Image size 1932x1910 — 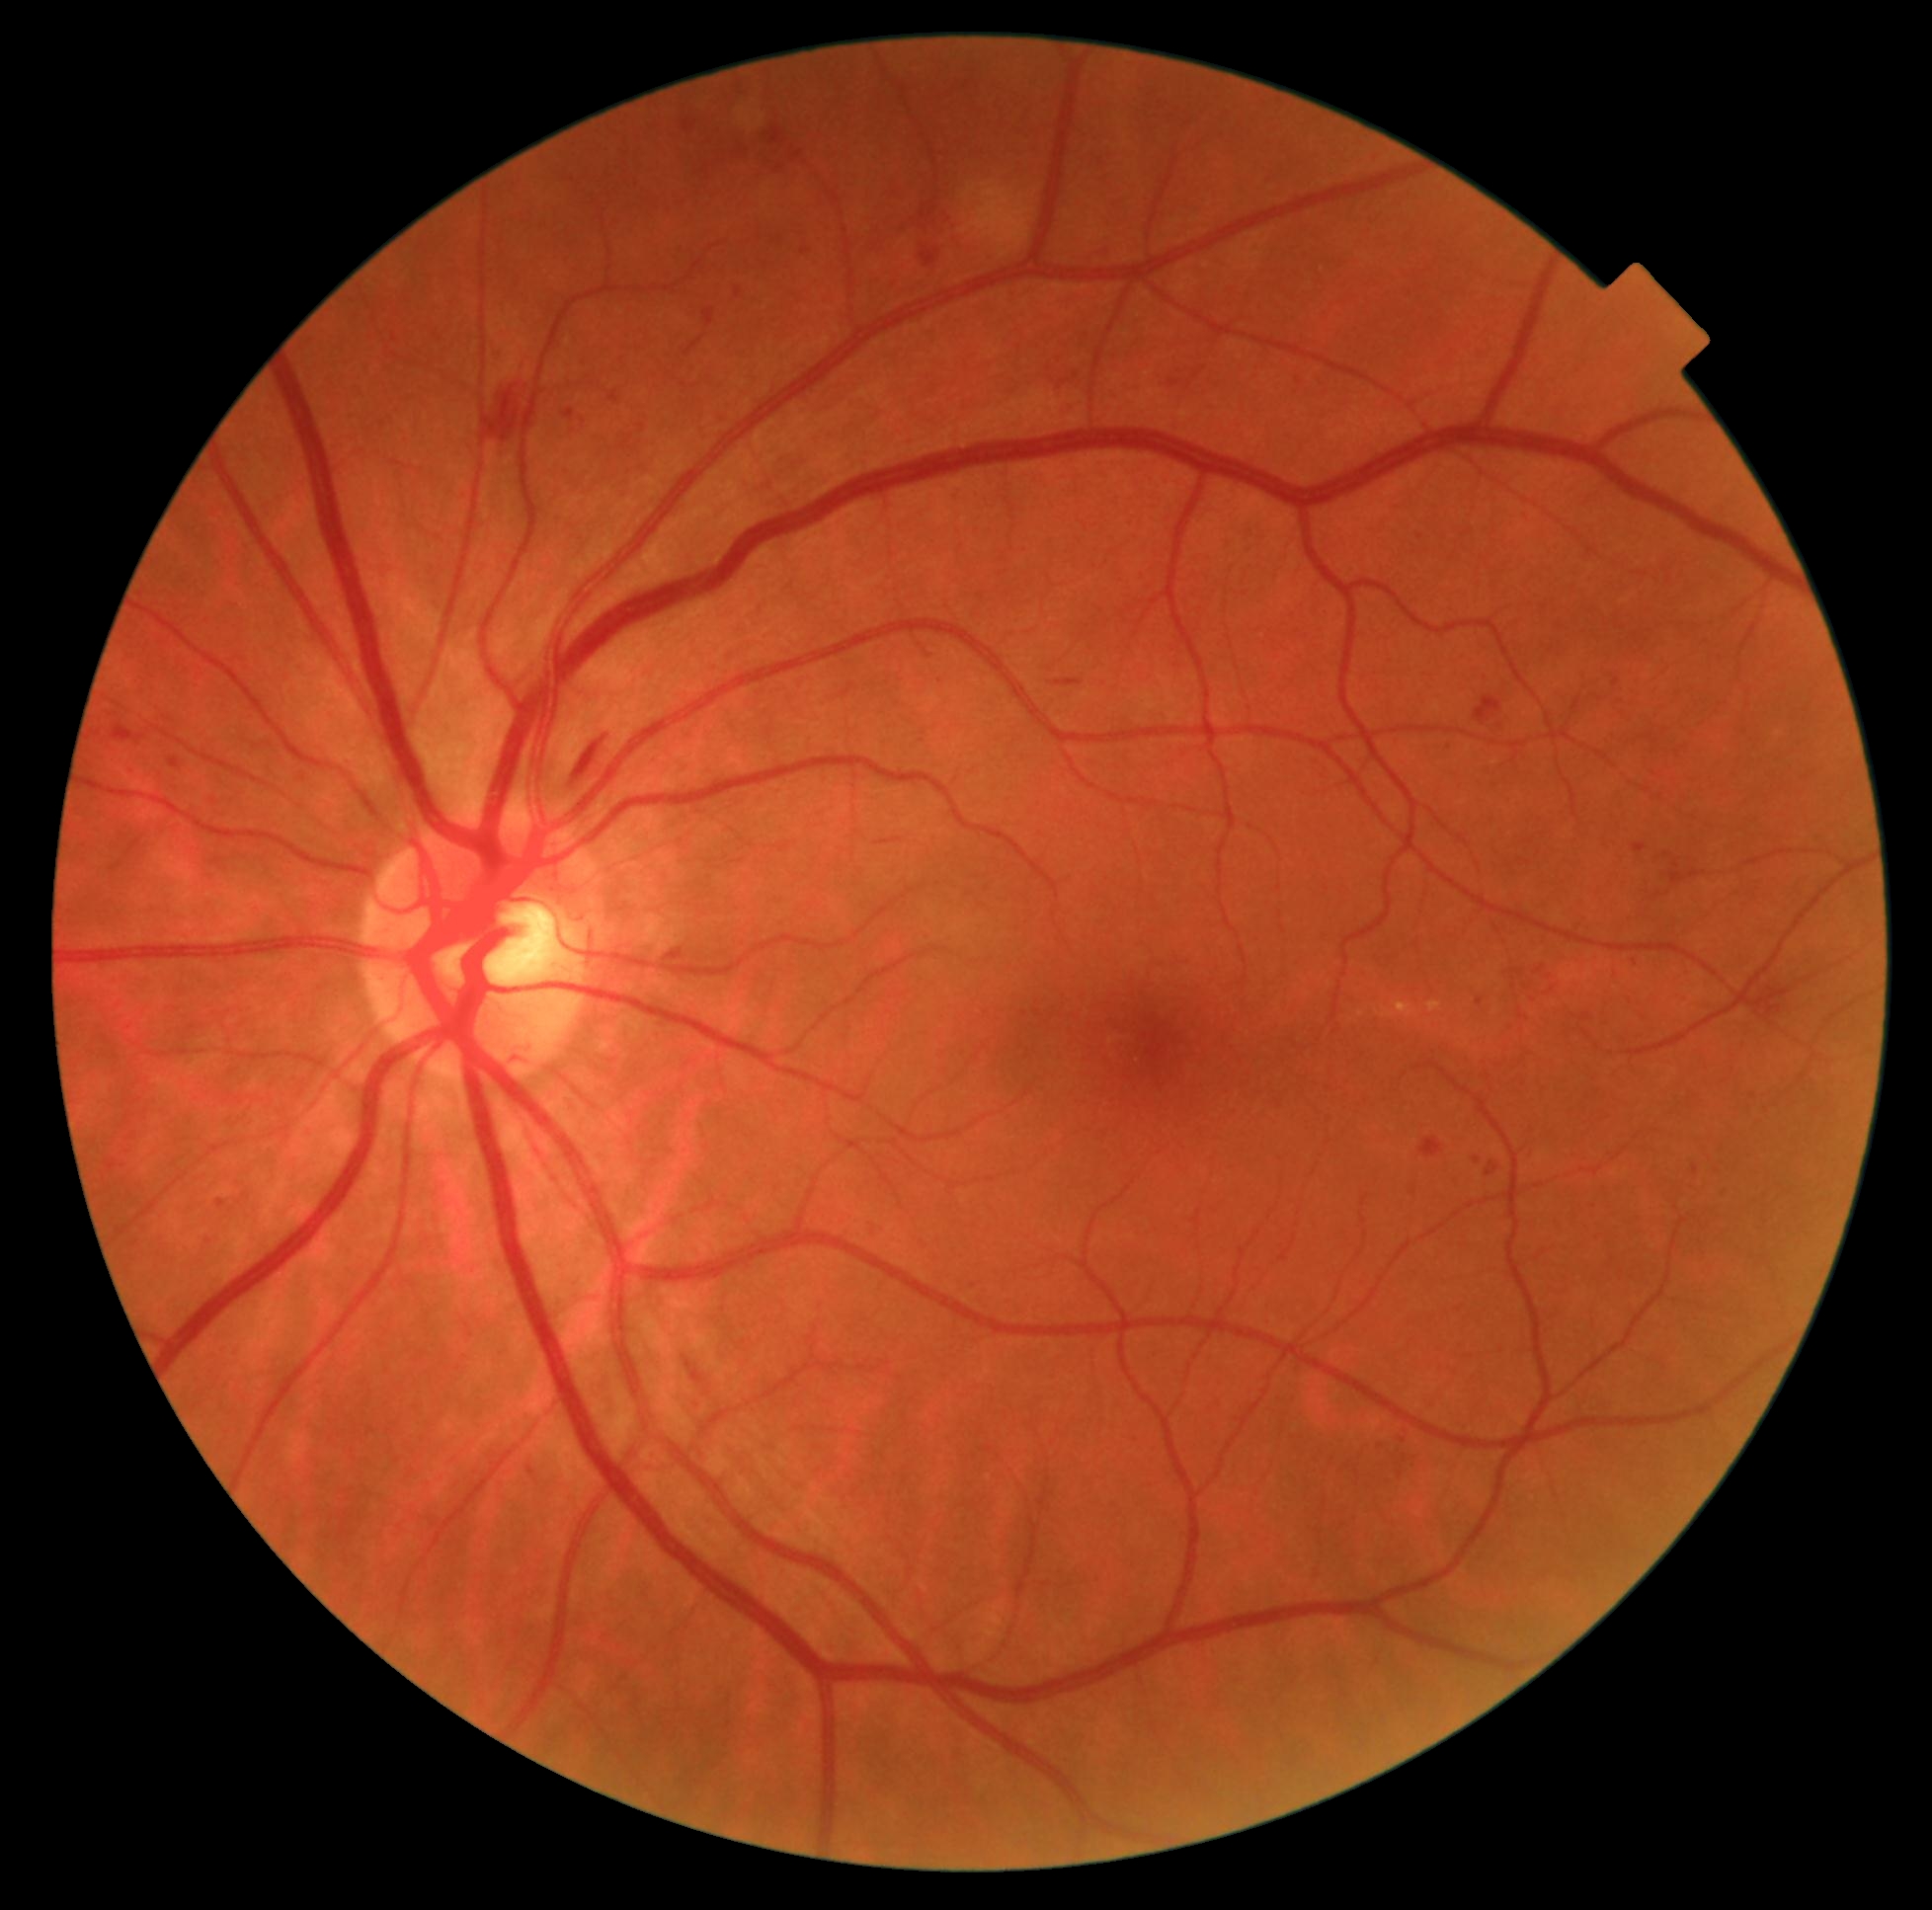
DR severity is grade 2.